NIDEK AFC-230 fundus camera:
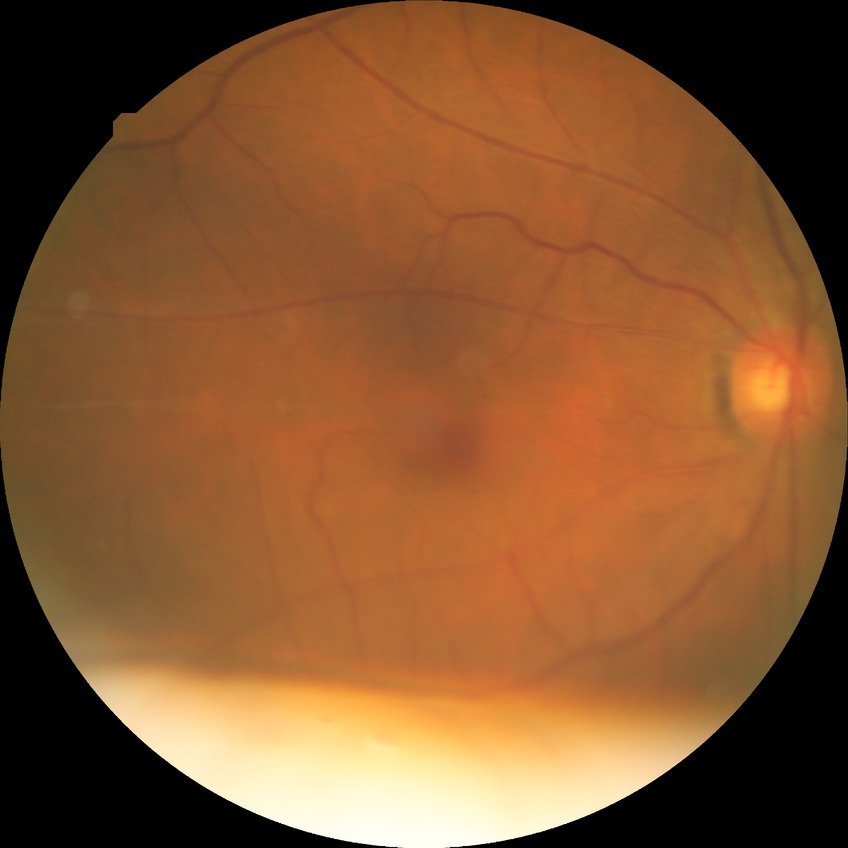 Davis DR grade: NDR.